Captured with the Phoenix ICON (100° field of view) · pediatric retinal photograph (wide-field)
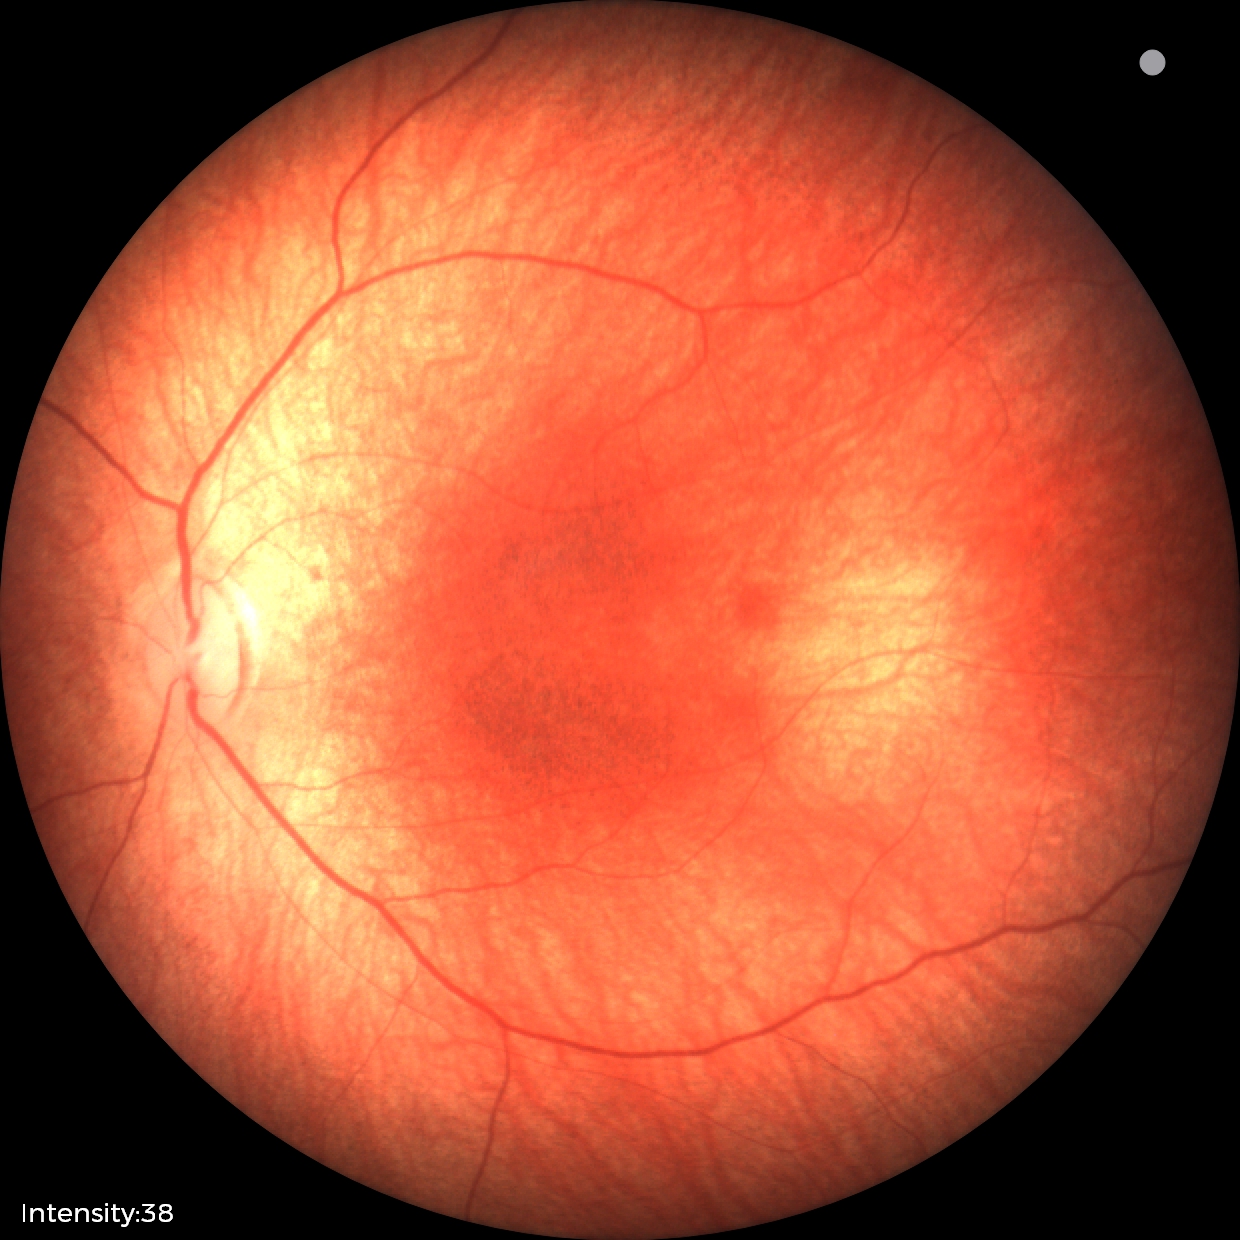 Assessment = physiological appearance.